Image size 1932x1916:
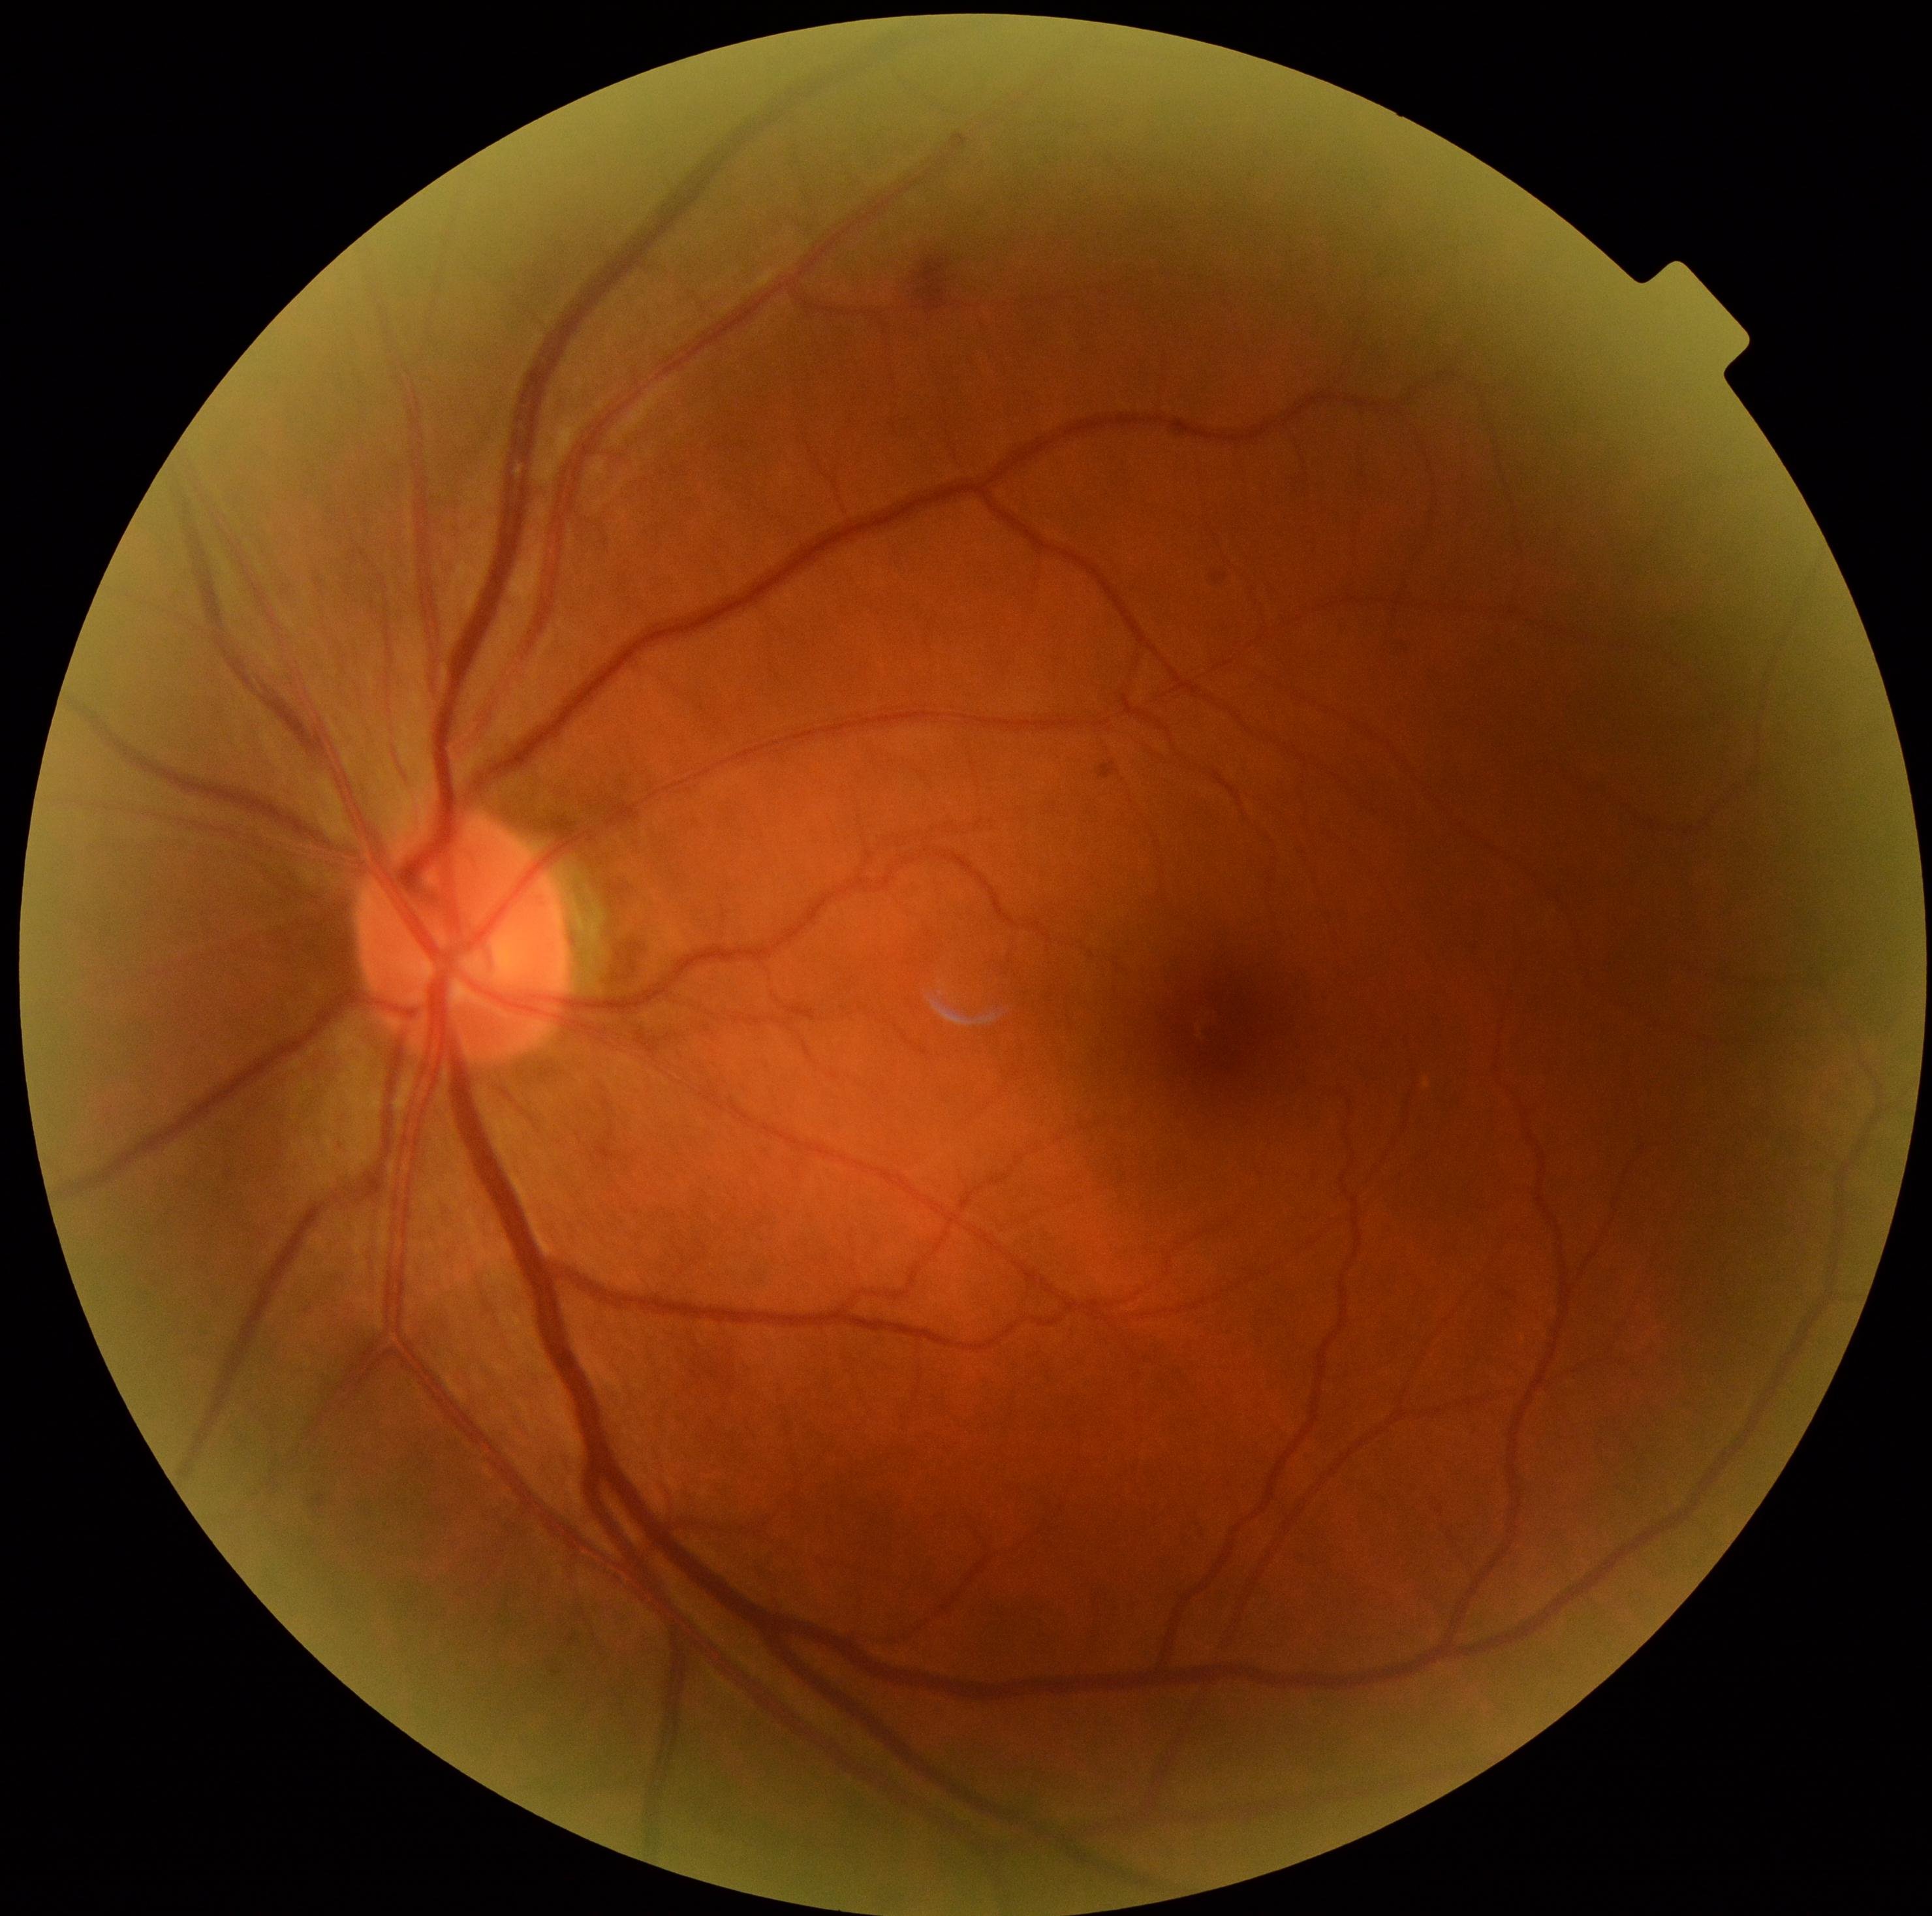
DR: grade 2.